Color fundus photograph
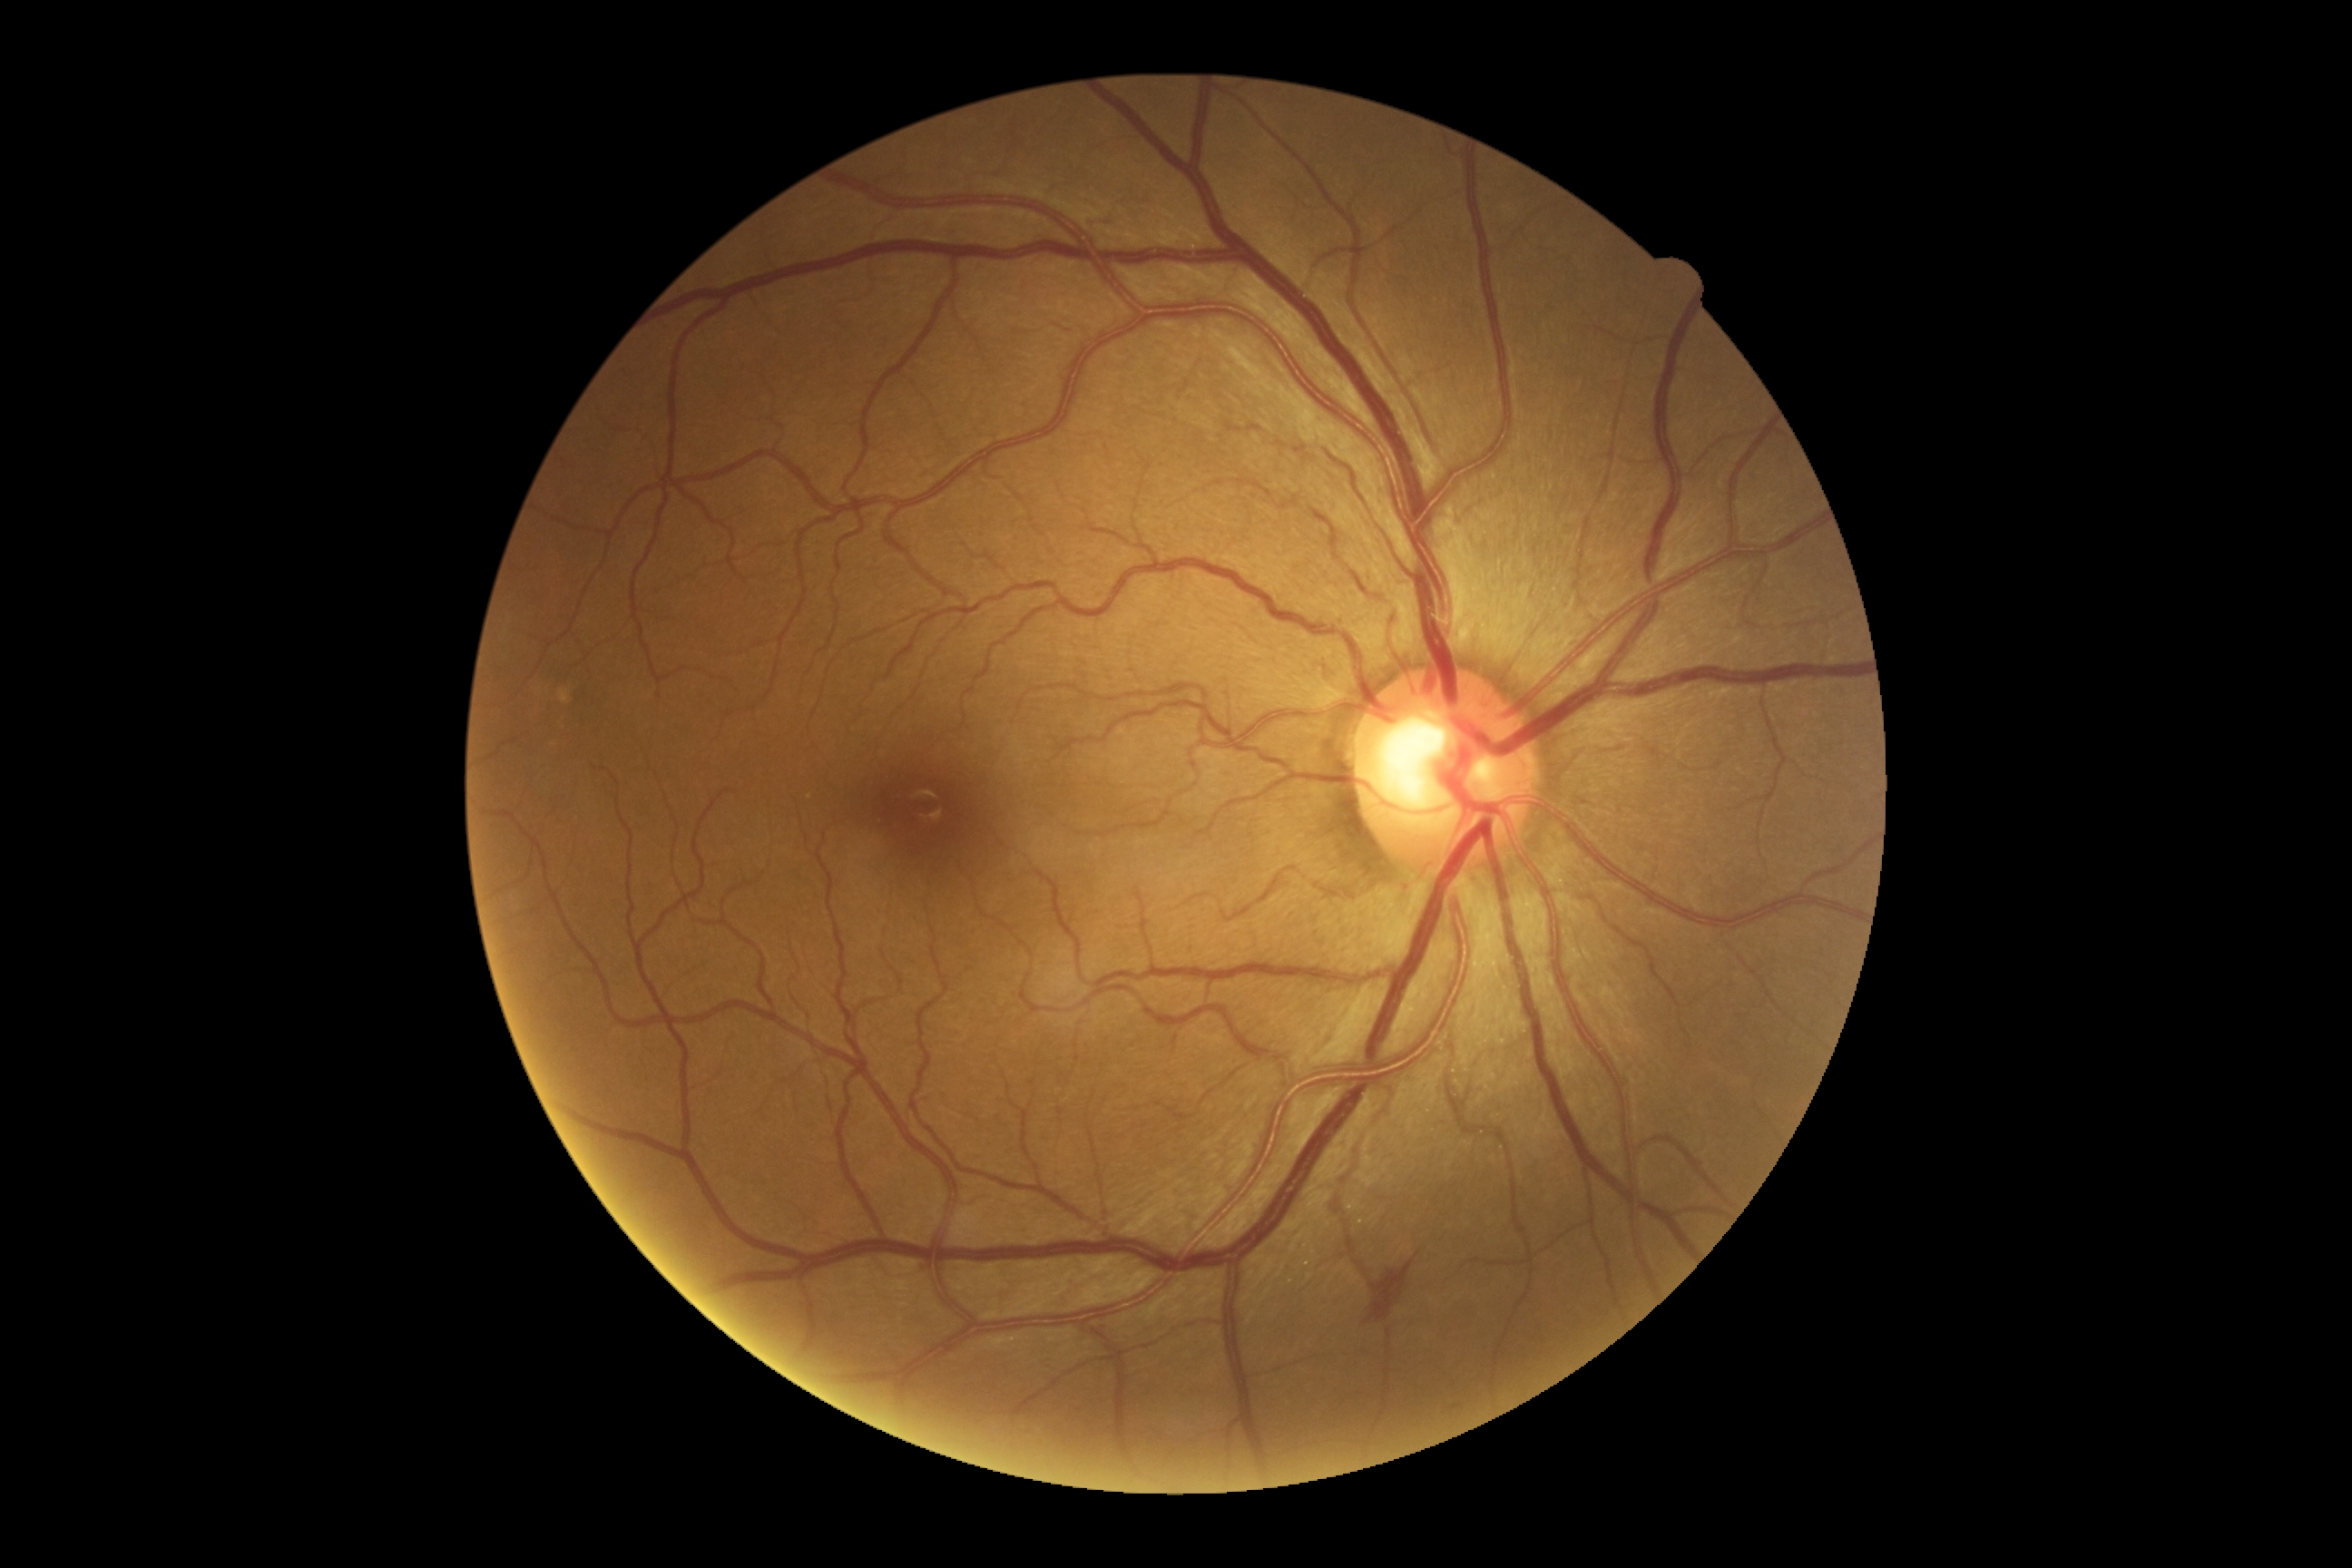

DR class: non-proliferative diabetic retinopathy
diabetic retinopathy (DR): grade 2 (moderate NPDR)